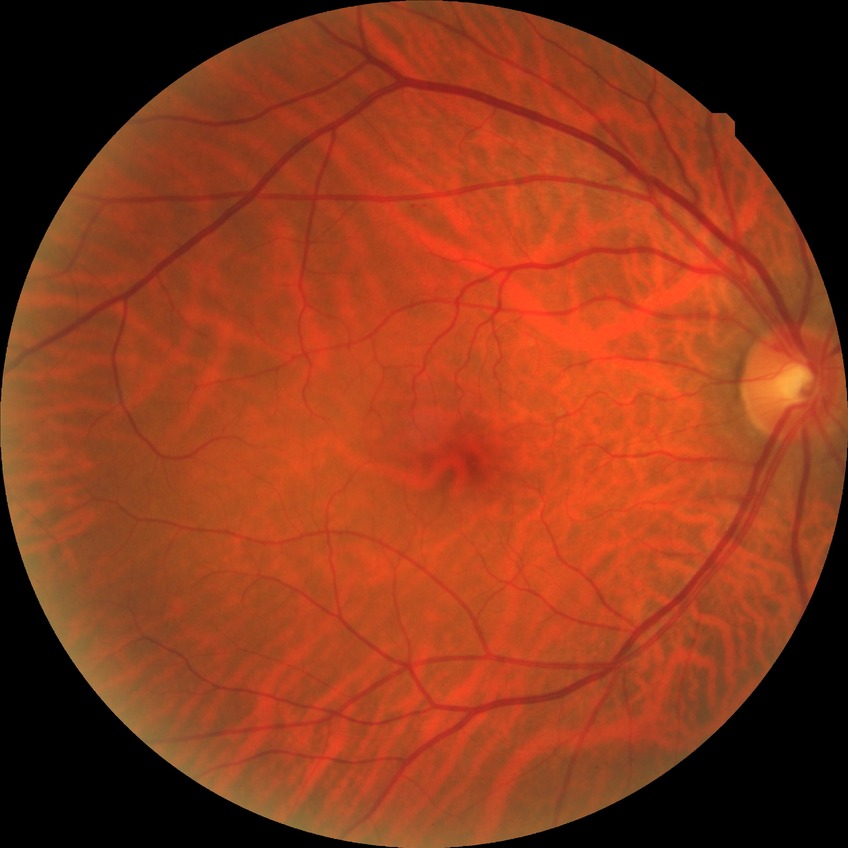
Diabetic retinopathy (DR) is NDR (no diabetic retinopathy).